1659 x 2212 pixels
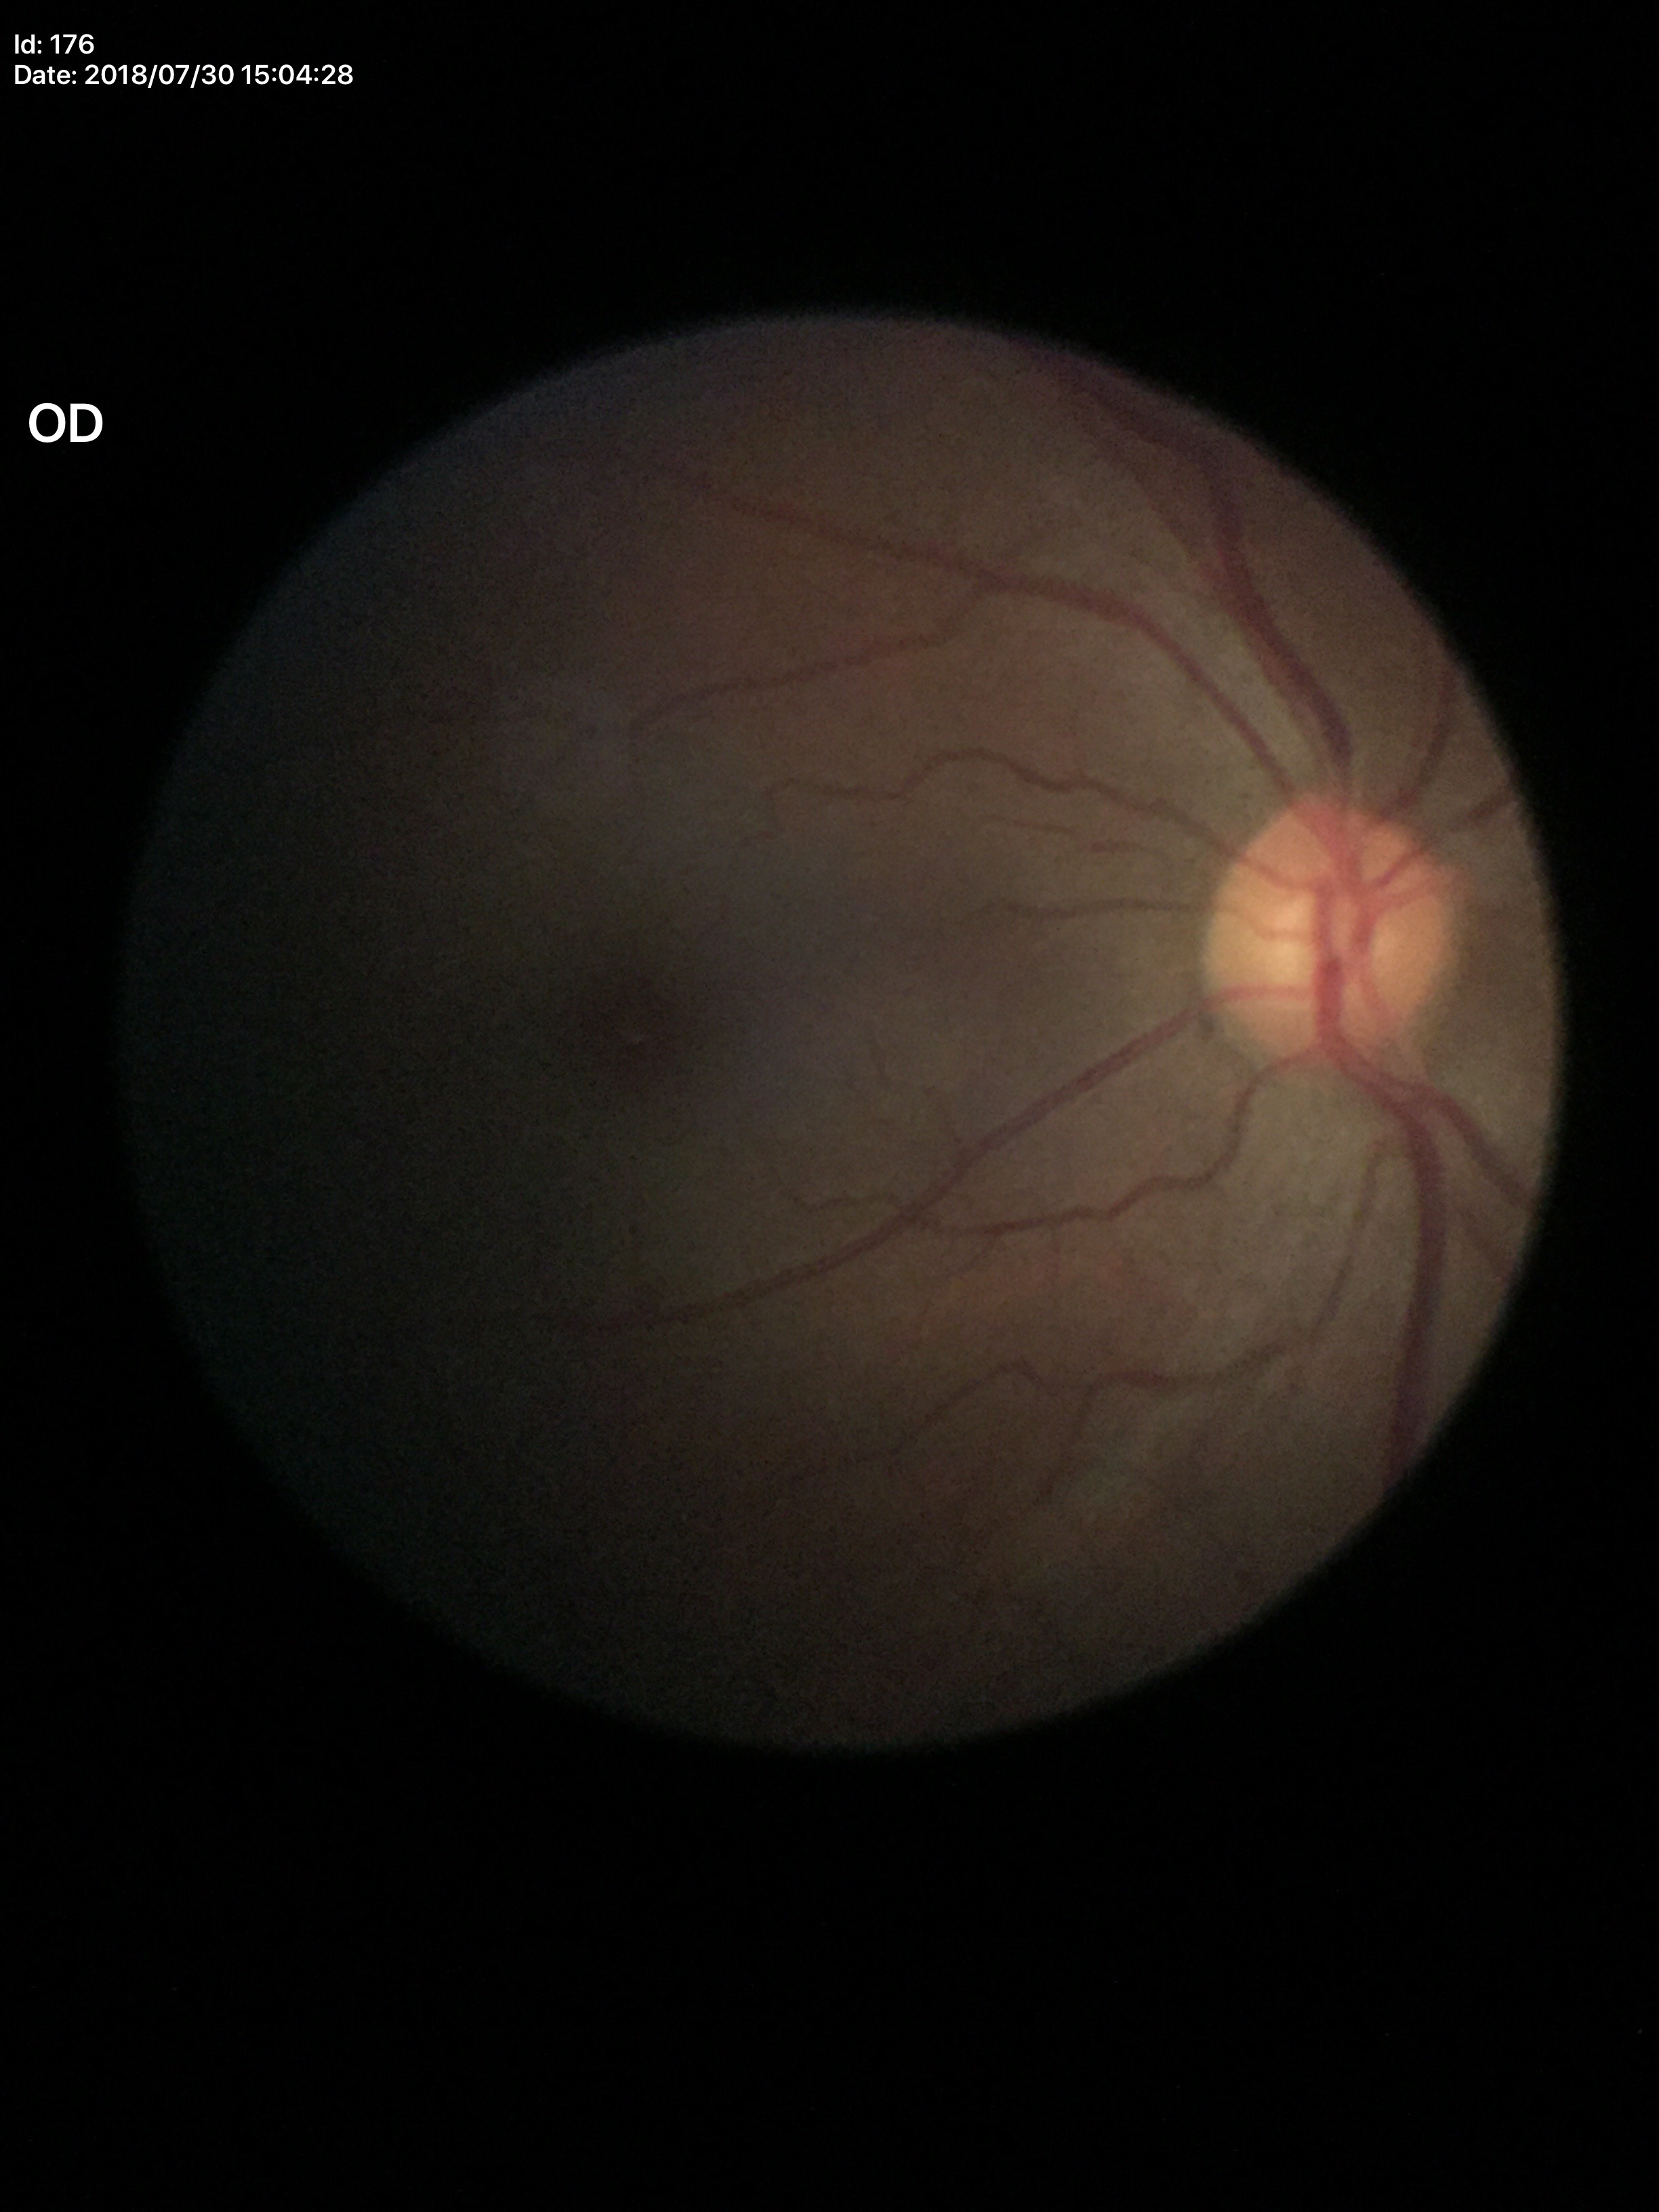 Findings:
– Glaucoma impression — not suspect
– vertical cup-to-disc ratio (VCDR) — 0.54